2048 x 1536 pixels: 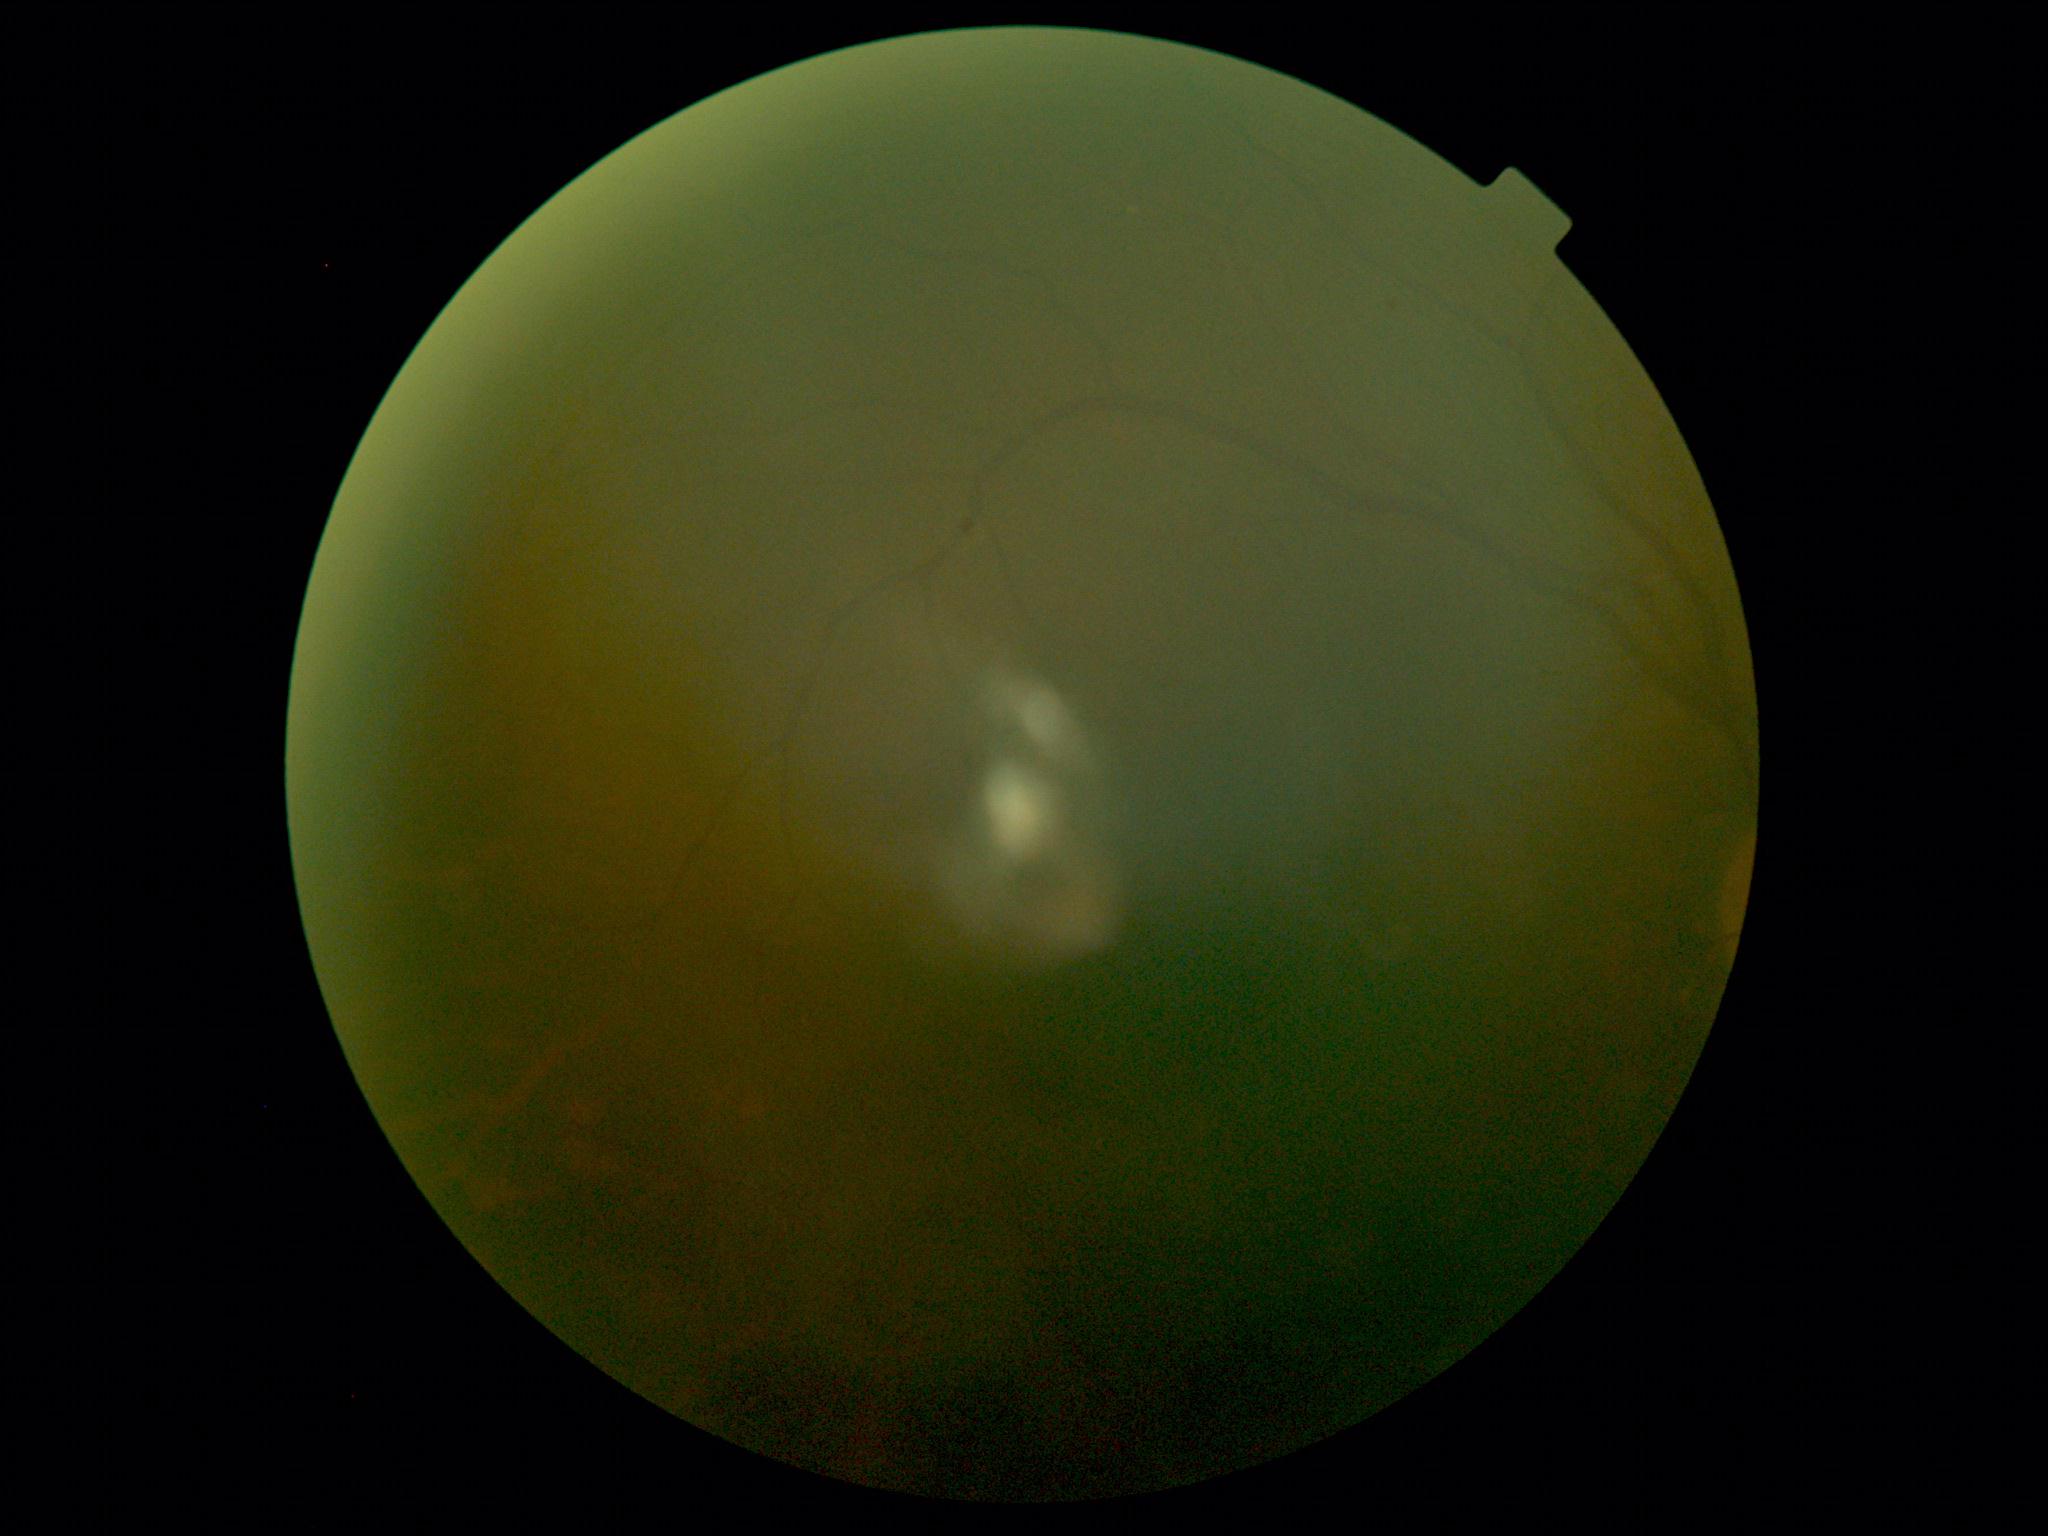
DR@ungradable due to poor image quality, image quality@below grading threshold.